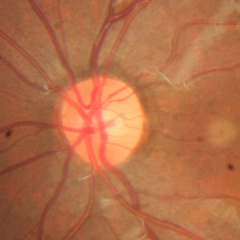
Q: Glaucoma assessment?
A: No glaucomatous findings.